Image size 1240x1240. Wide-field fundus image from infant ROP screening — 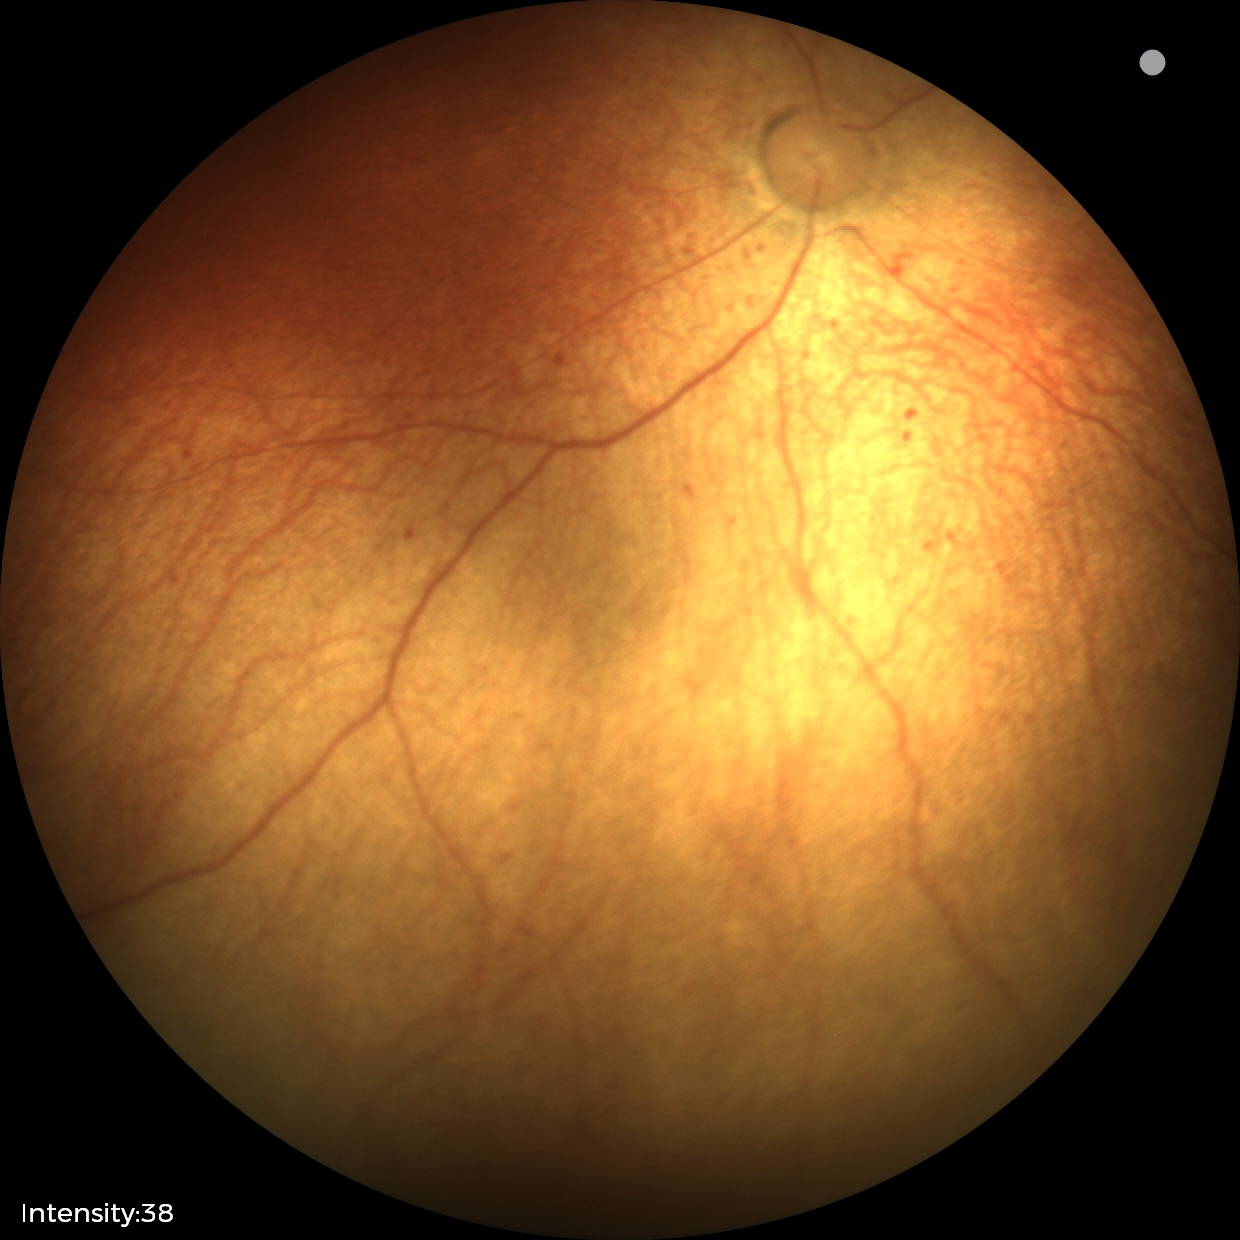 Plus disease absent. Diagnosis from this screening exam: status post retinopathy of prematurity.